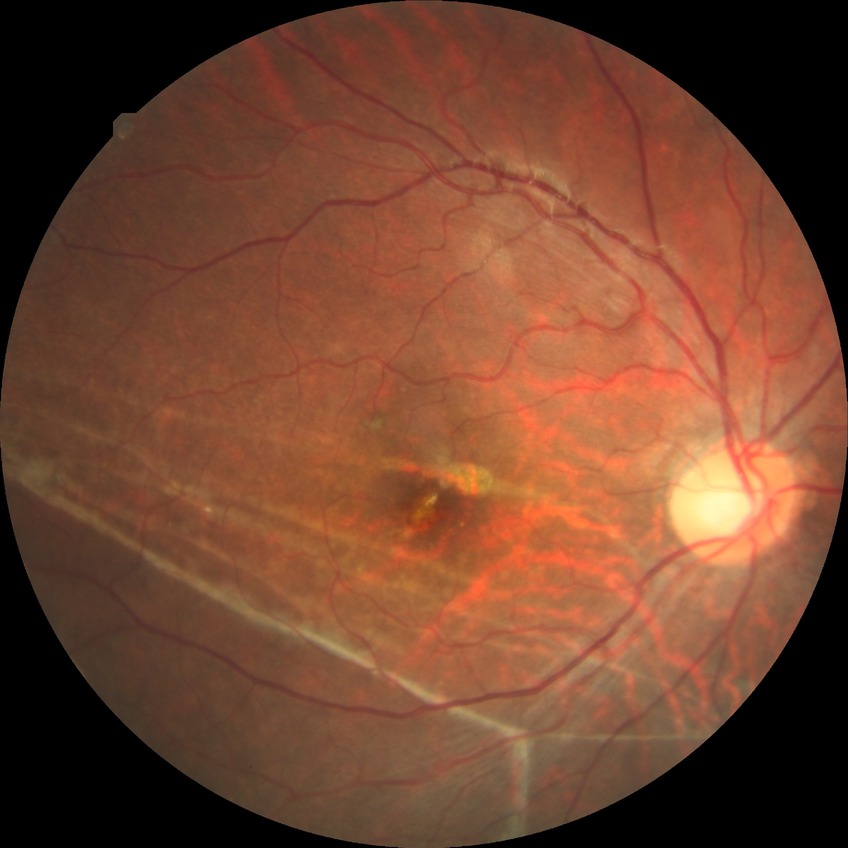

diabetic retinopathy (DR): NDR (no diabetic retinopathy).